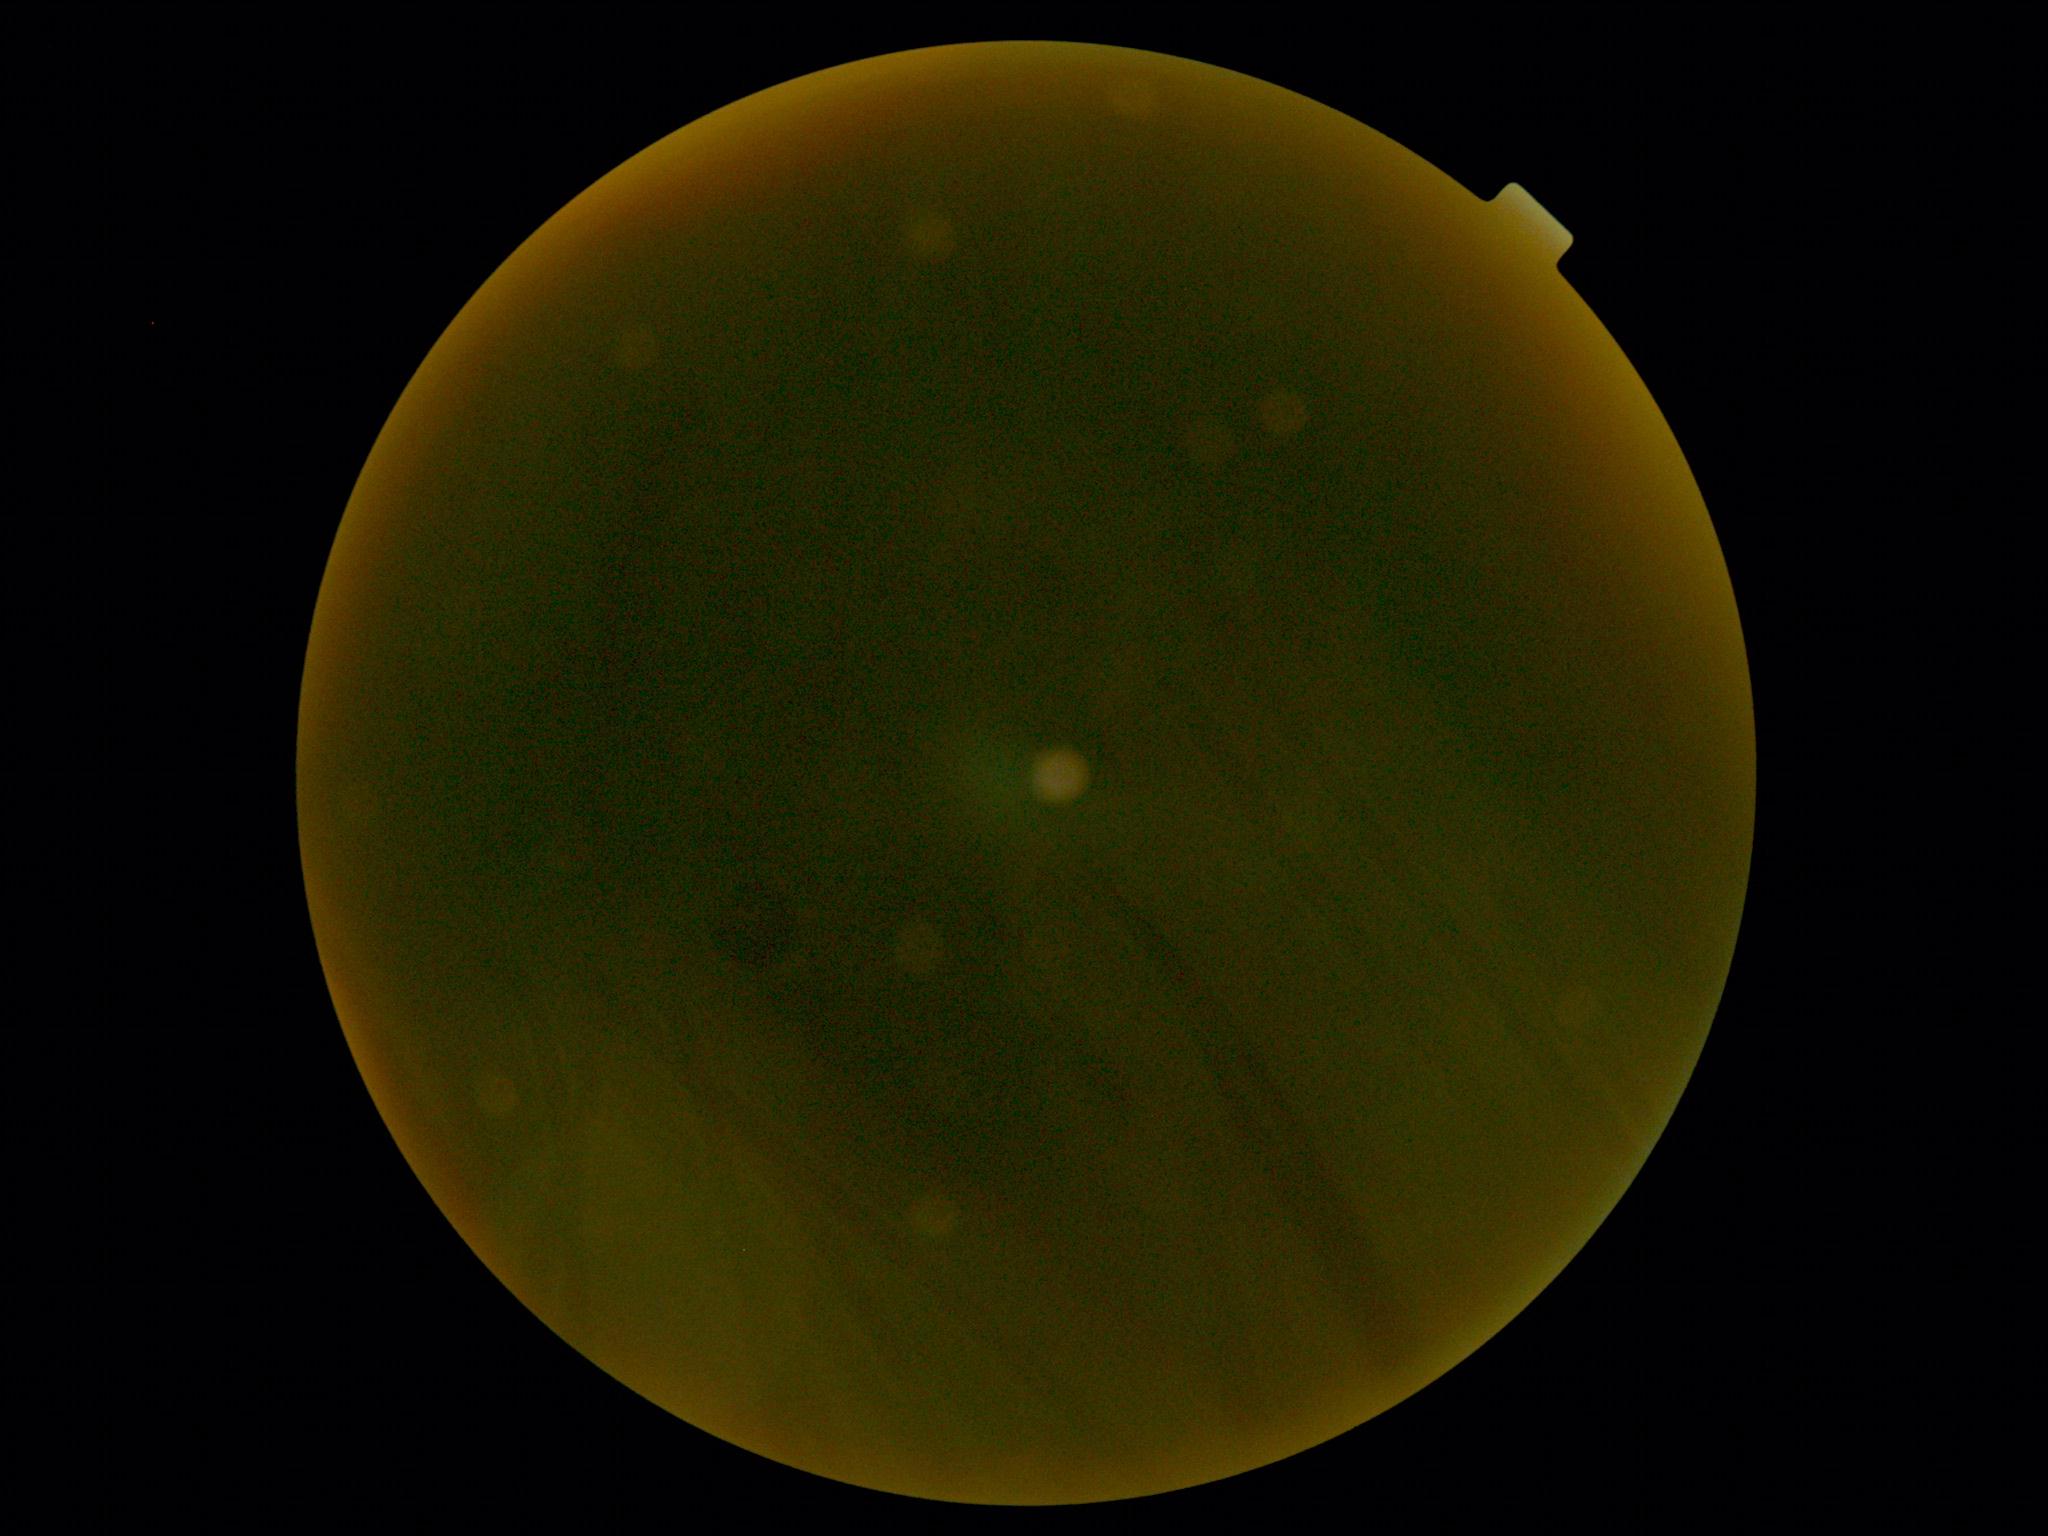 DR stage = ungradable due to poor image quality.